Fundus photo · no pharmacologic dilation · 45° field of view
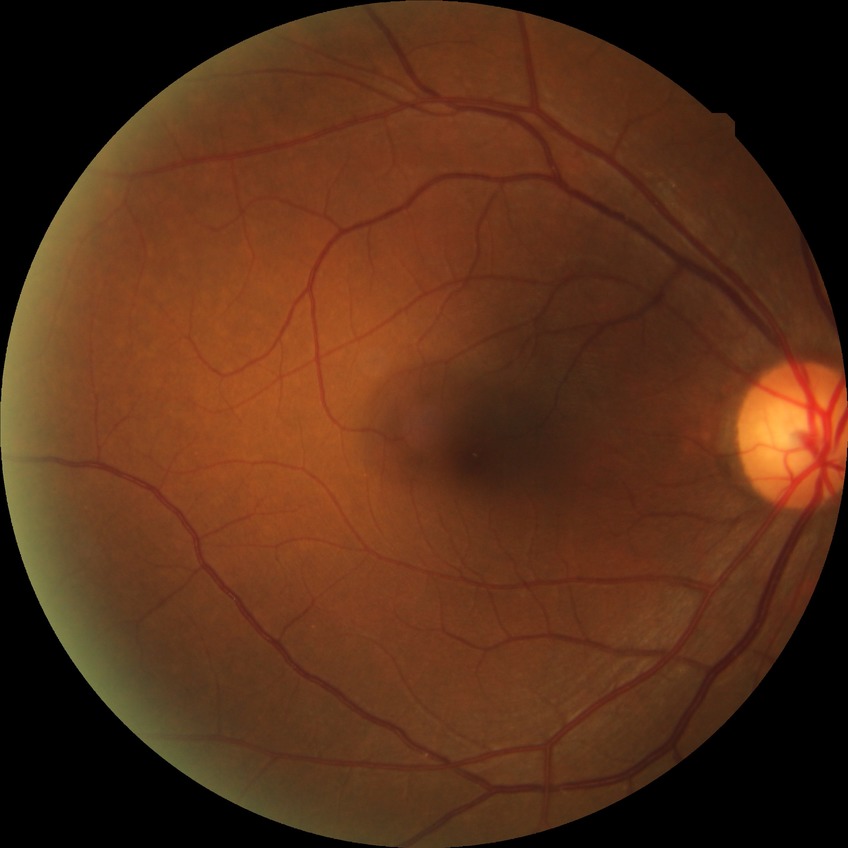
Assessment:
* diabetic retinopathy (DR): no diabetic retinopathy (NDR)